Without pupil dilation. NIDEK AFC-230. Davis DR grading. 848 x 848 pixels — 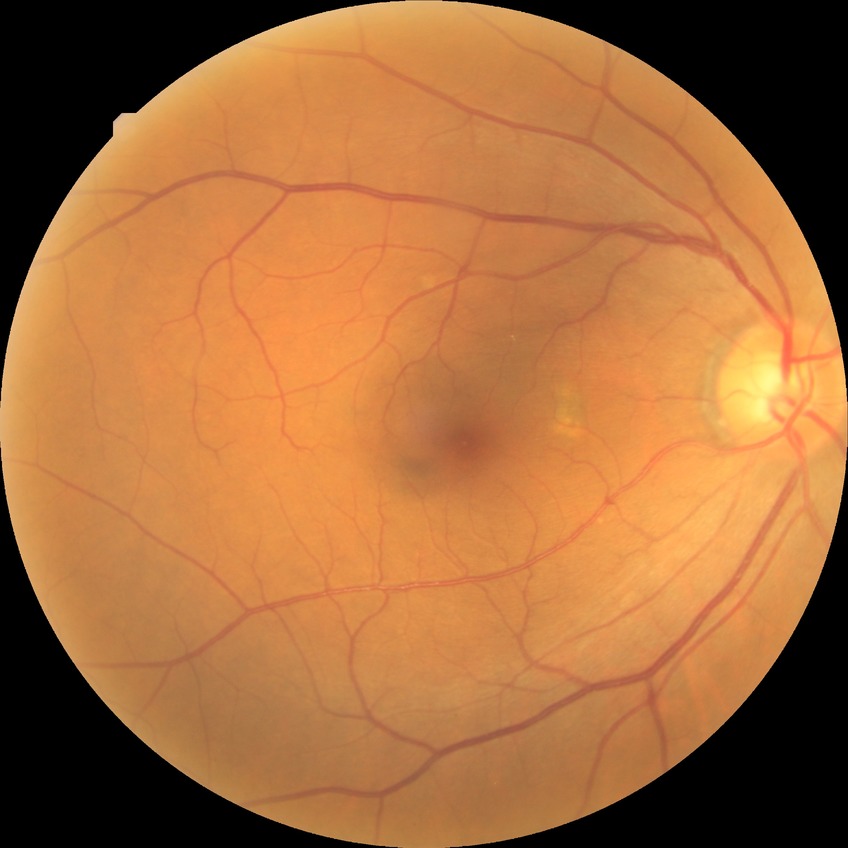

Diabetic retinopathy (DR) is NDR (no diabetic retinopathy).